45° FOV; CFP; image size 2048x1536:
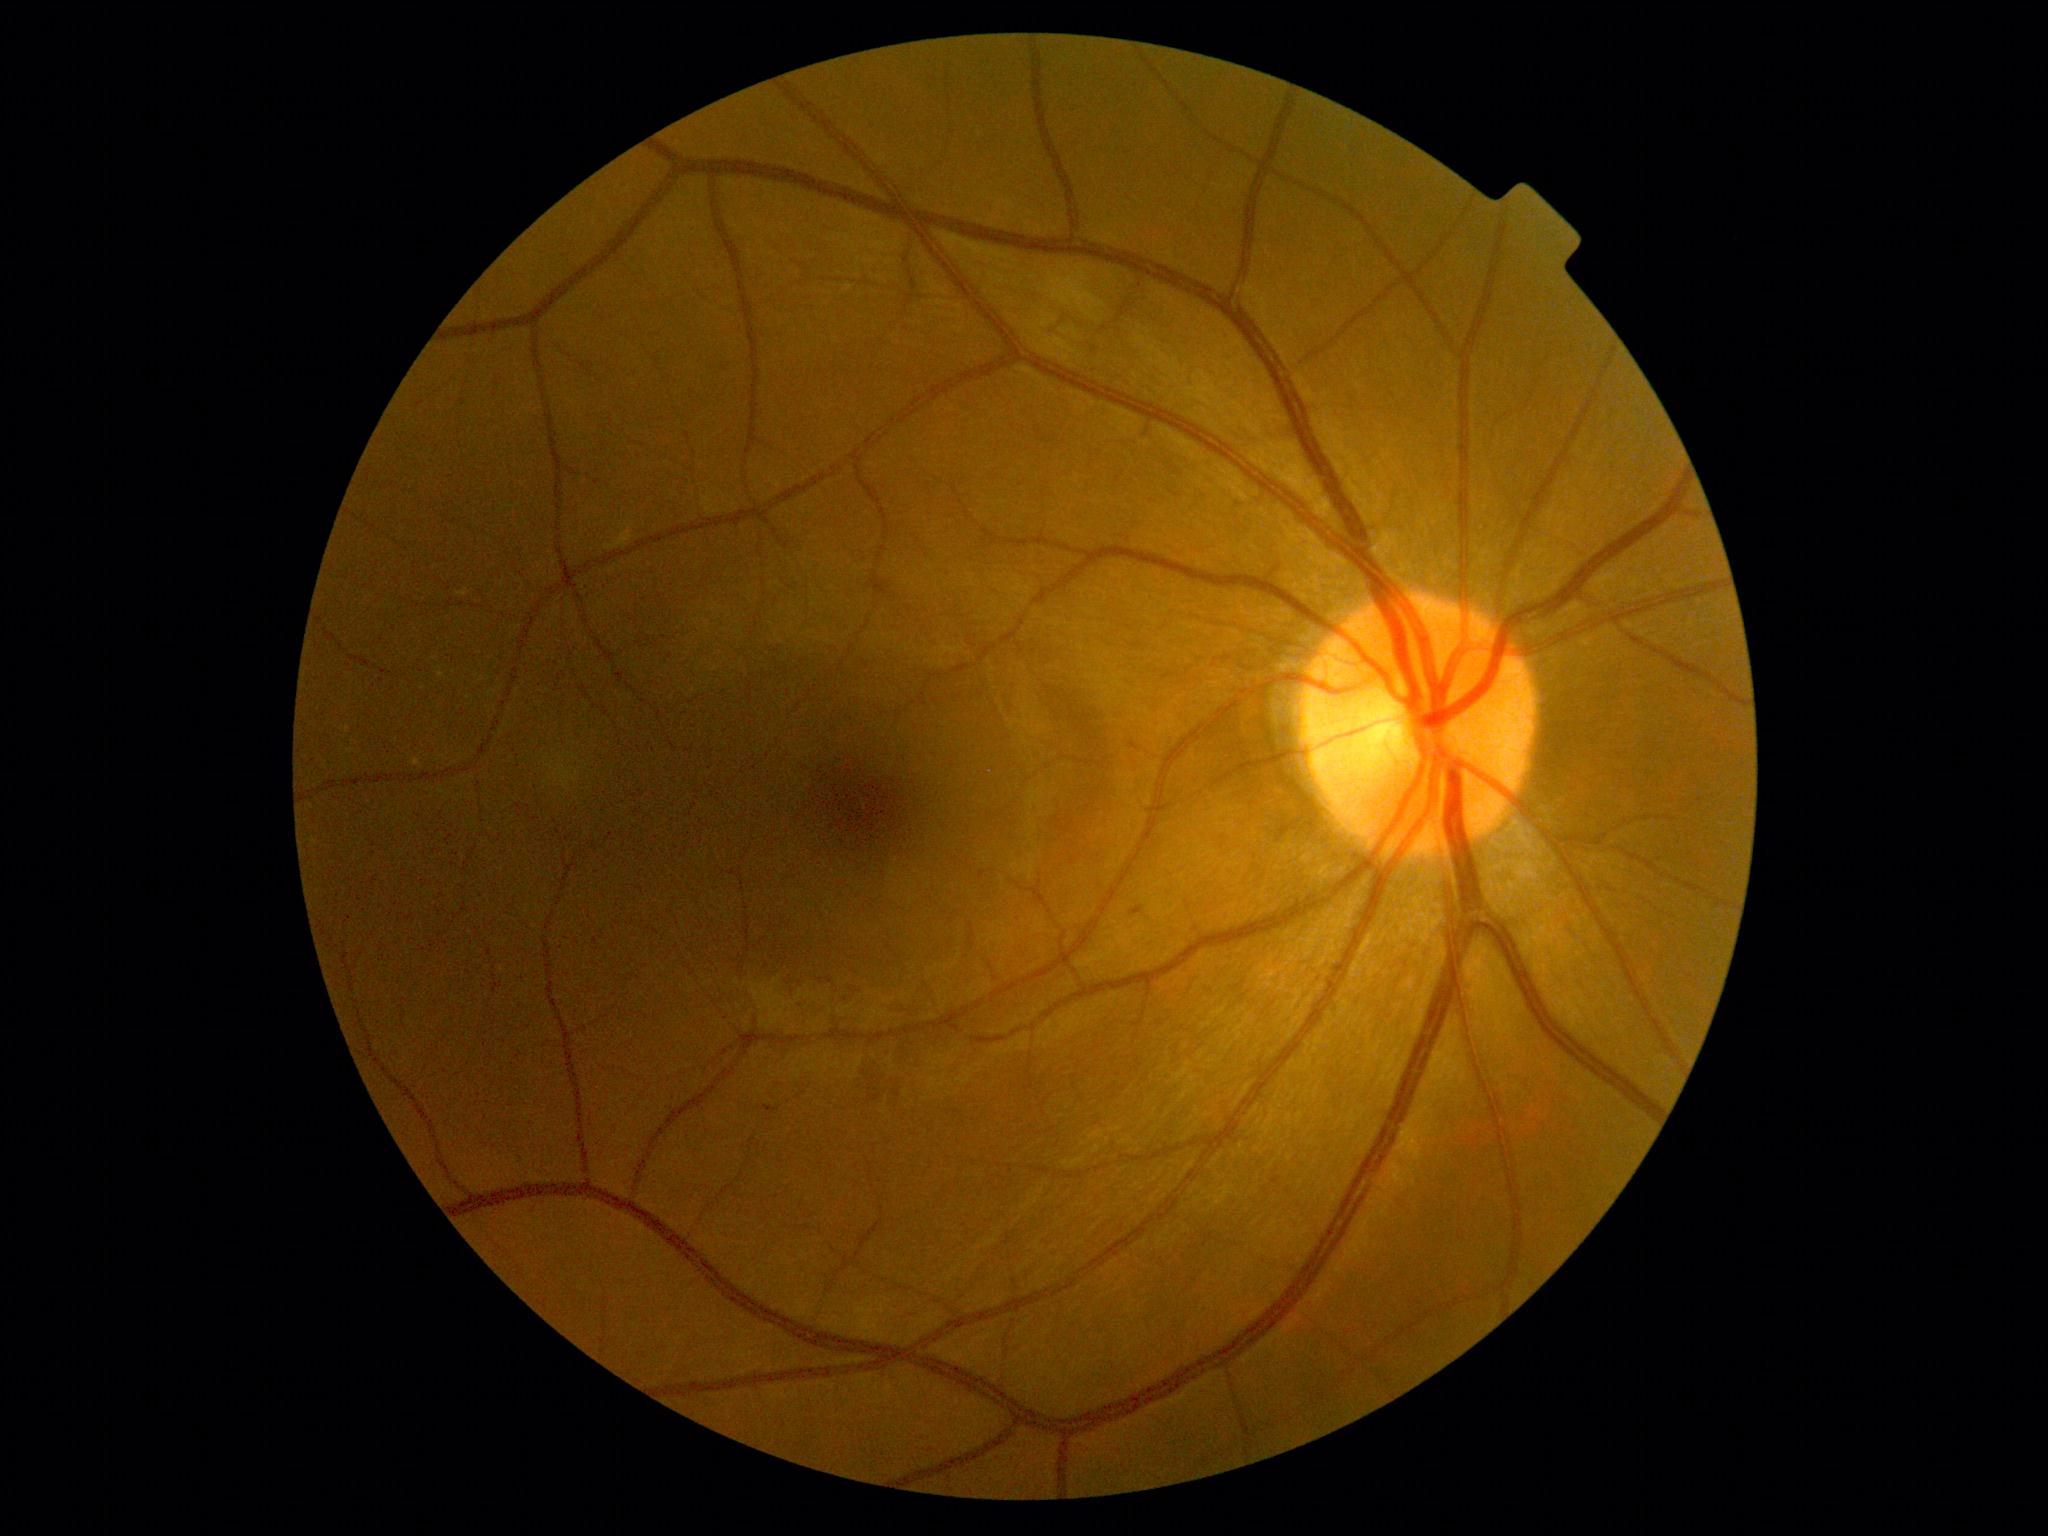
DR severity: grade 1.